45° FOV: 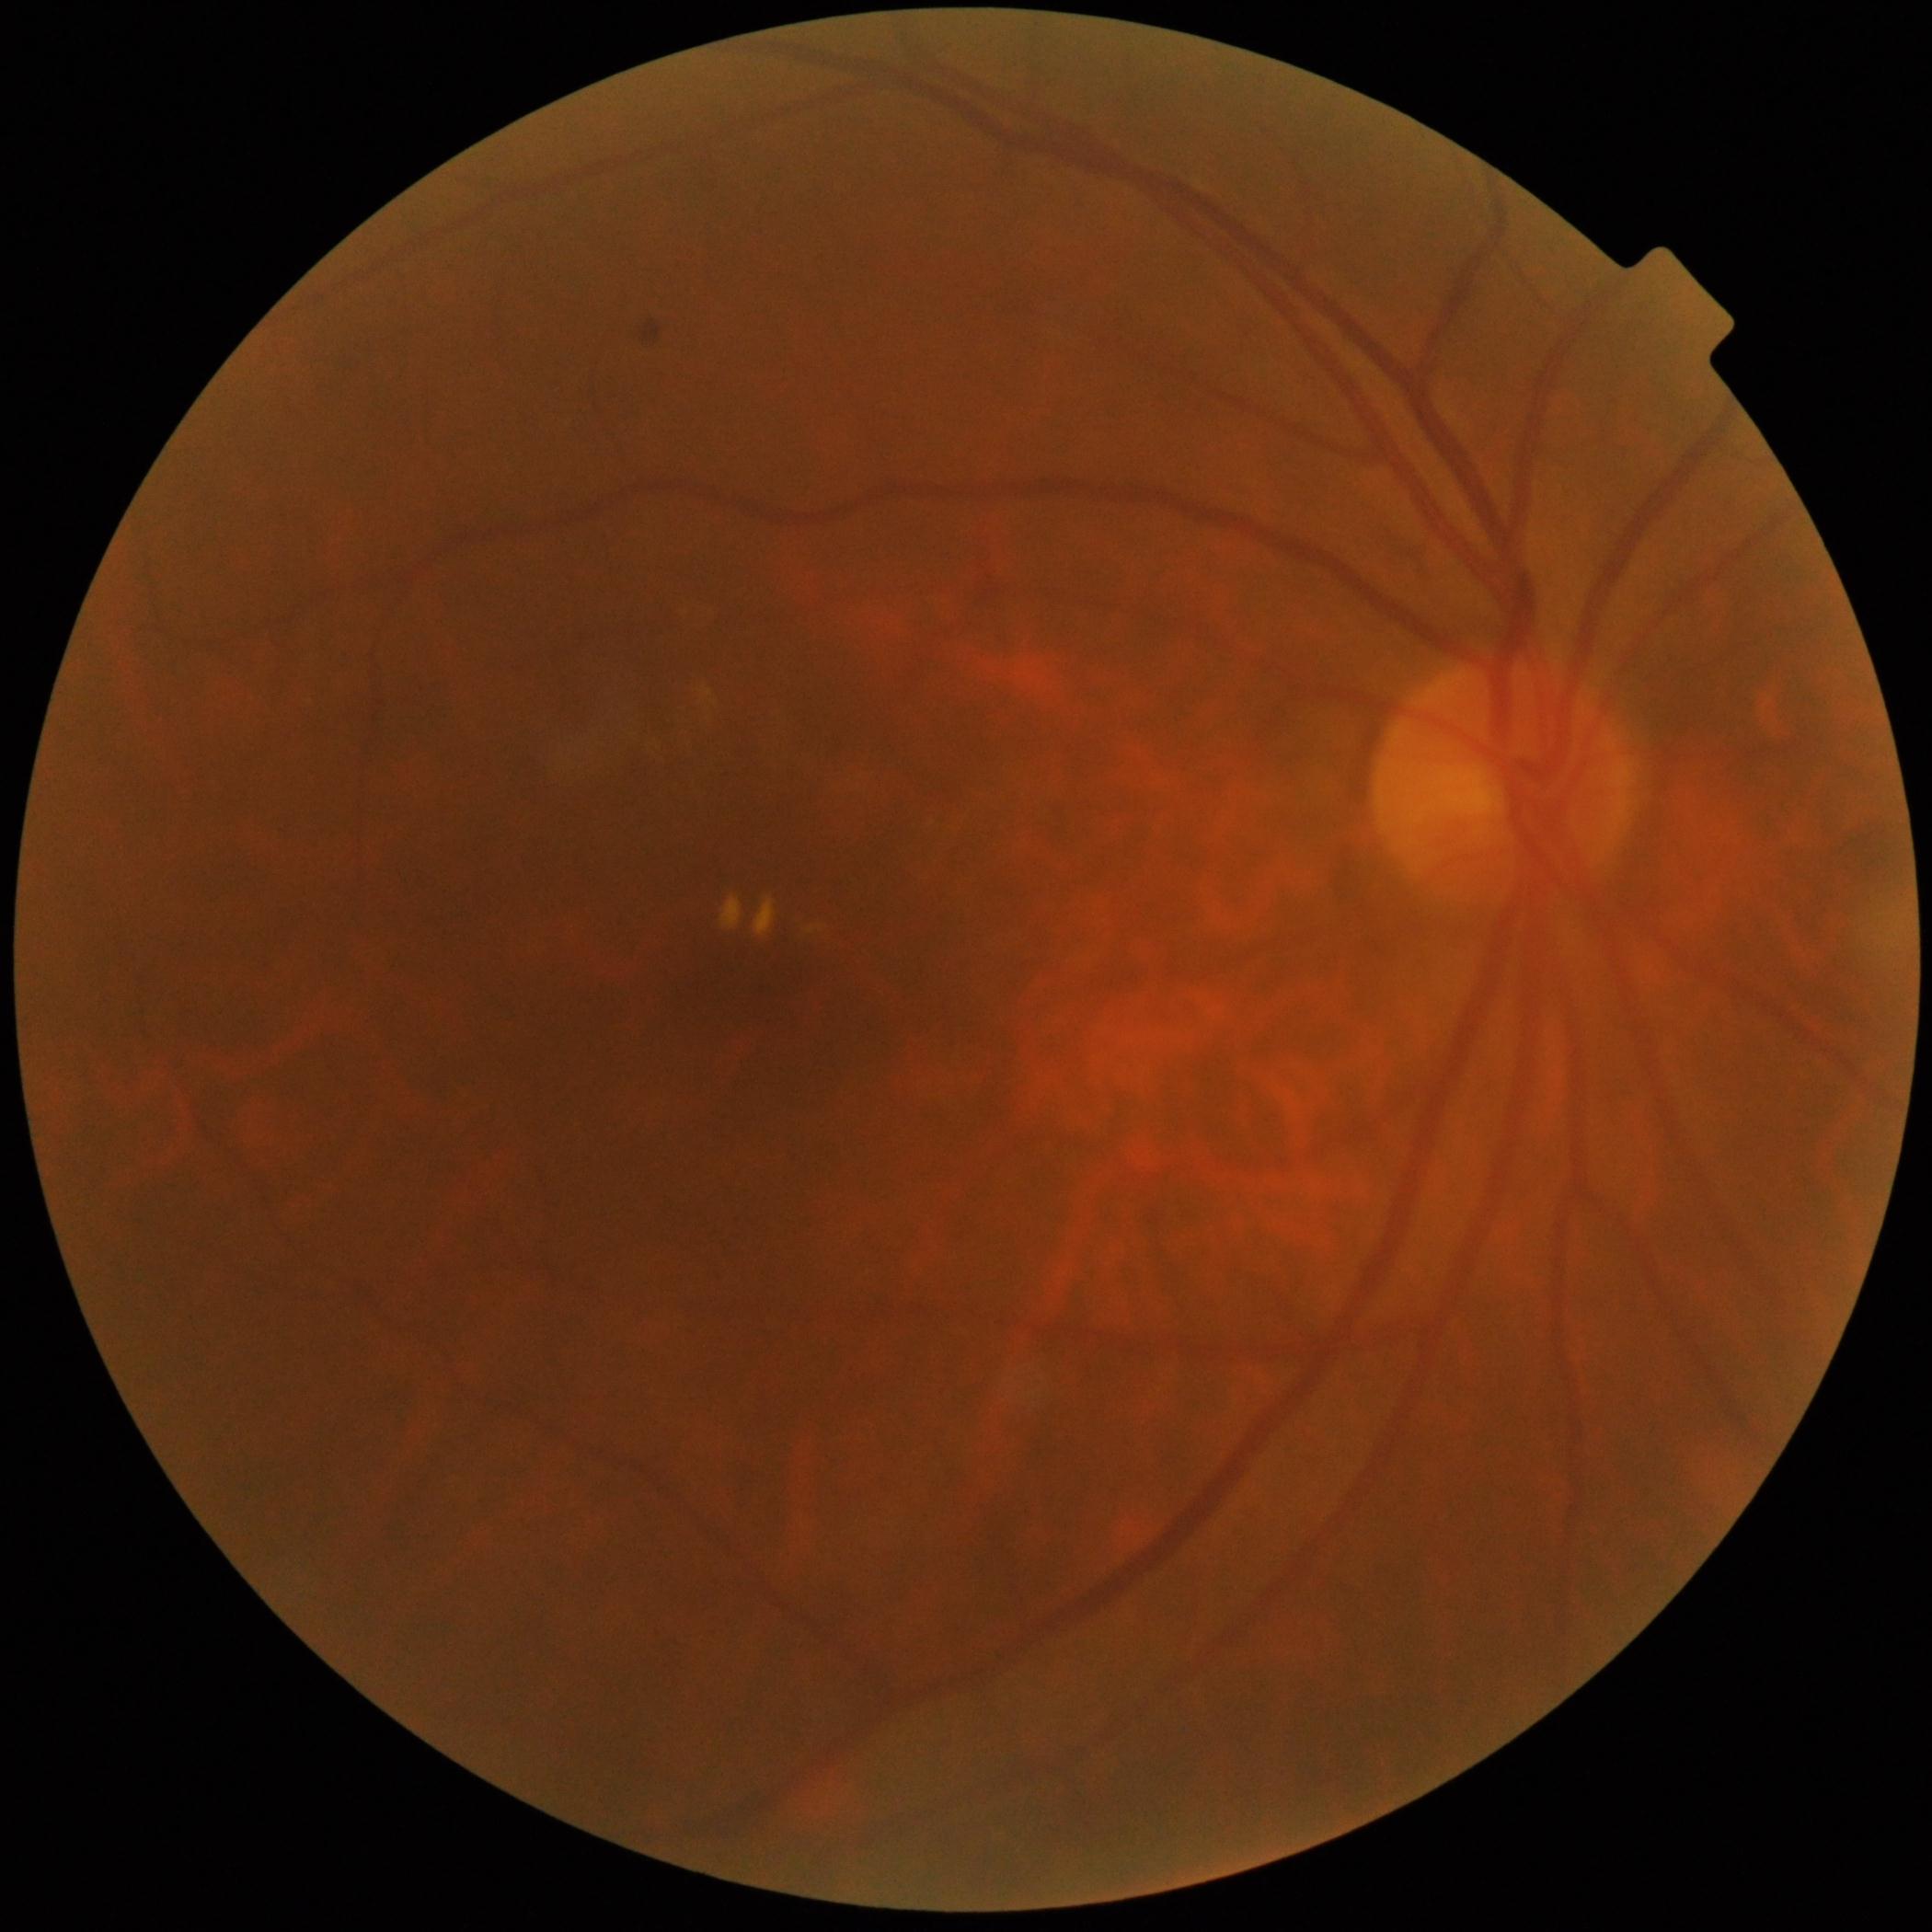   dr_grade: 2 — more than just microaneurysms but less than severe NPDR